Retinal fundus photograph.
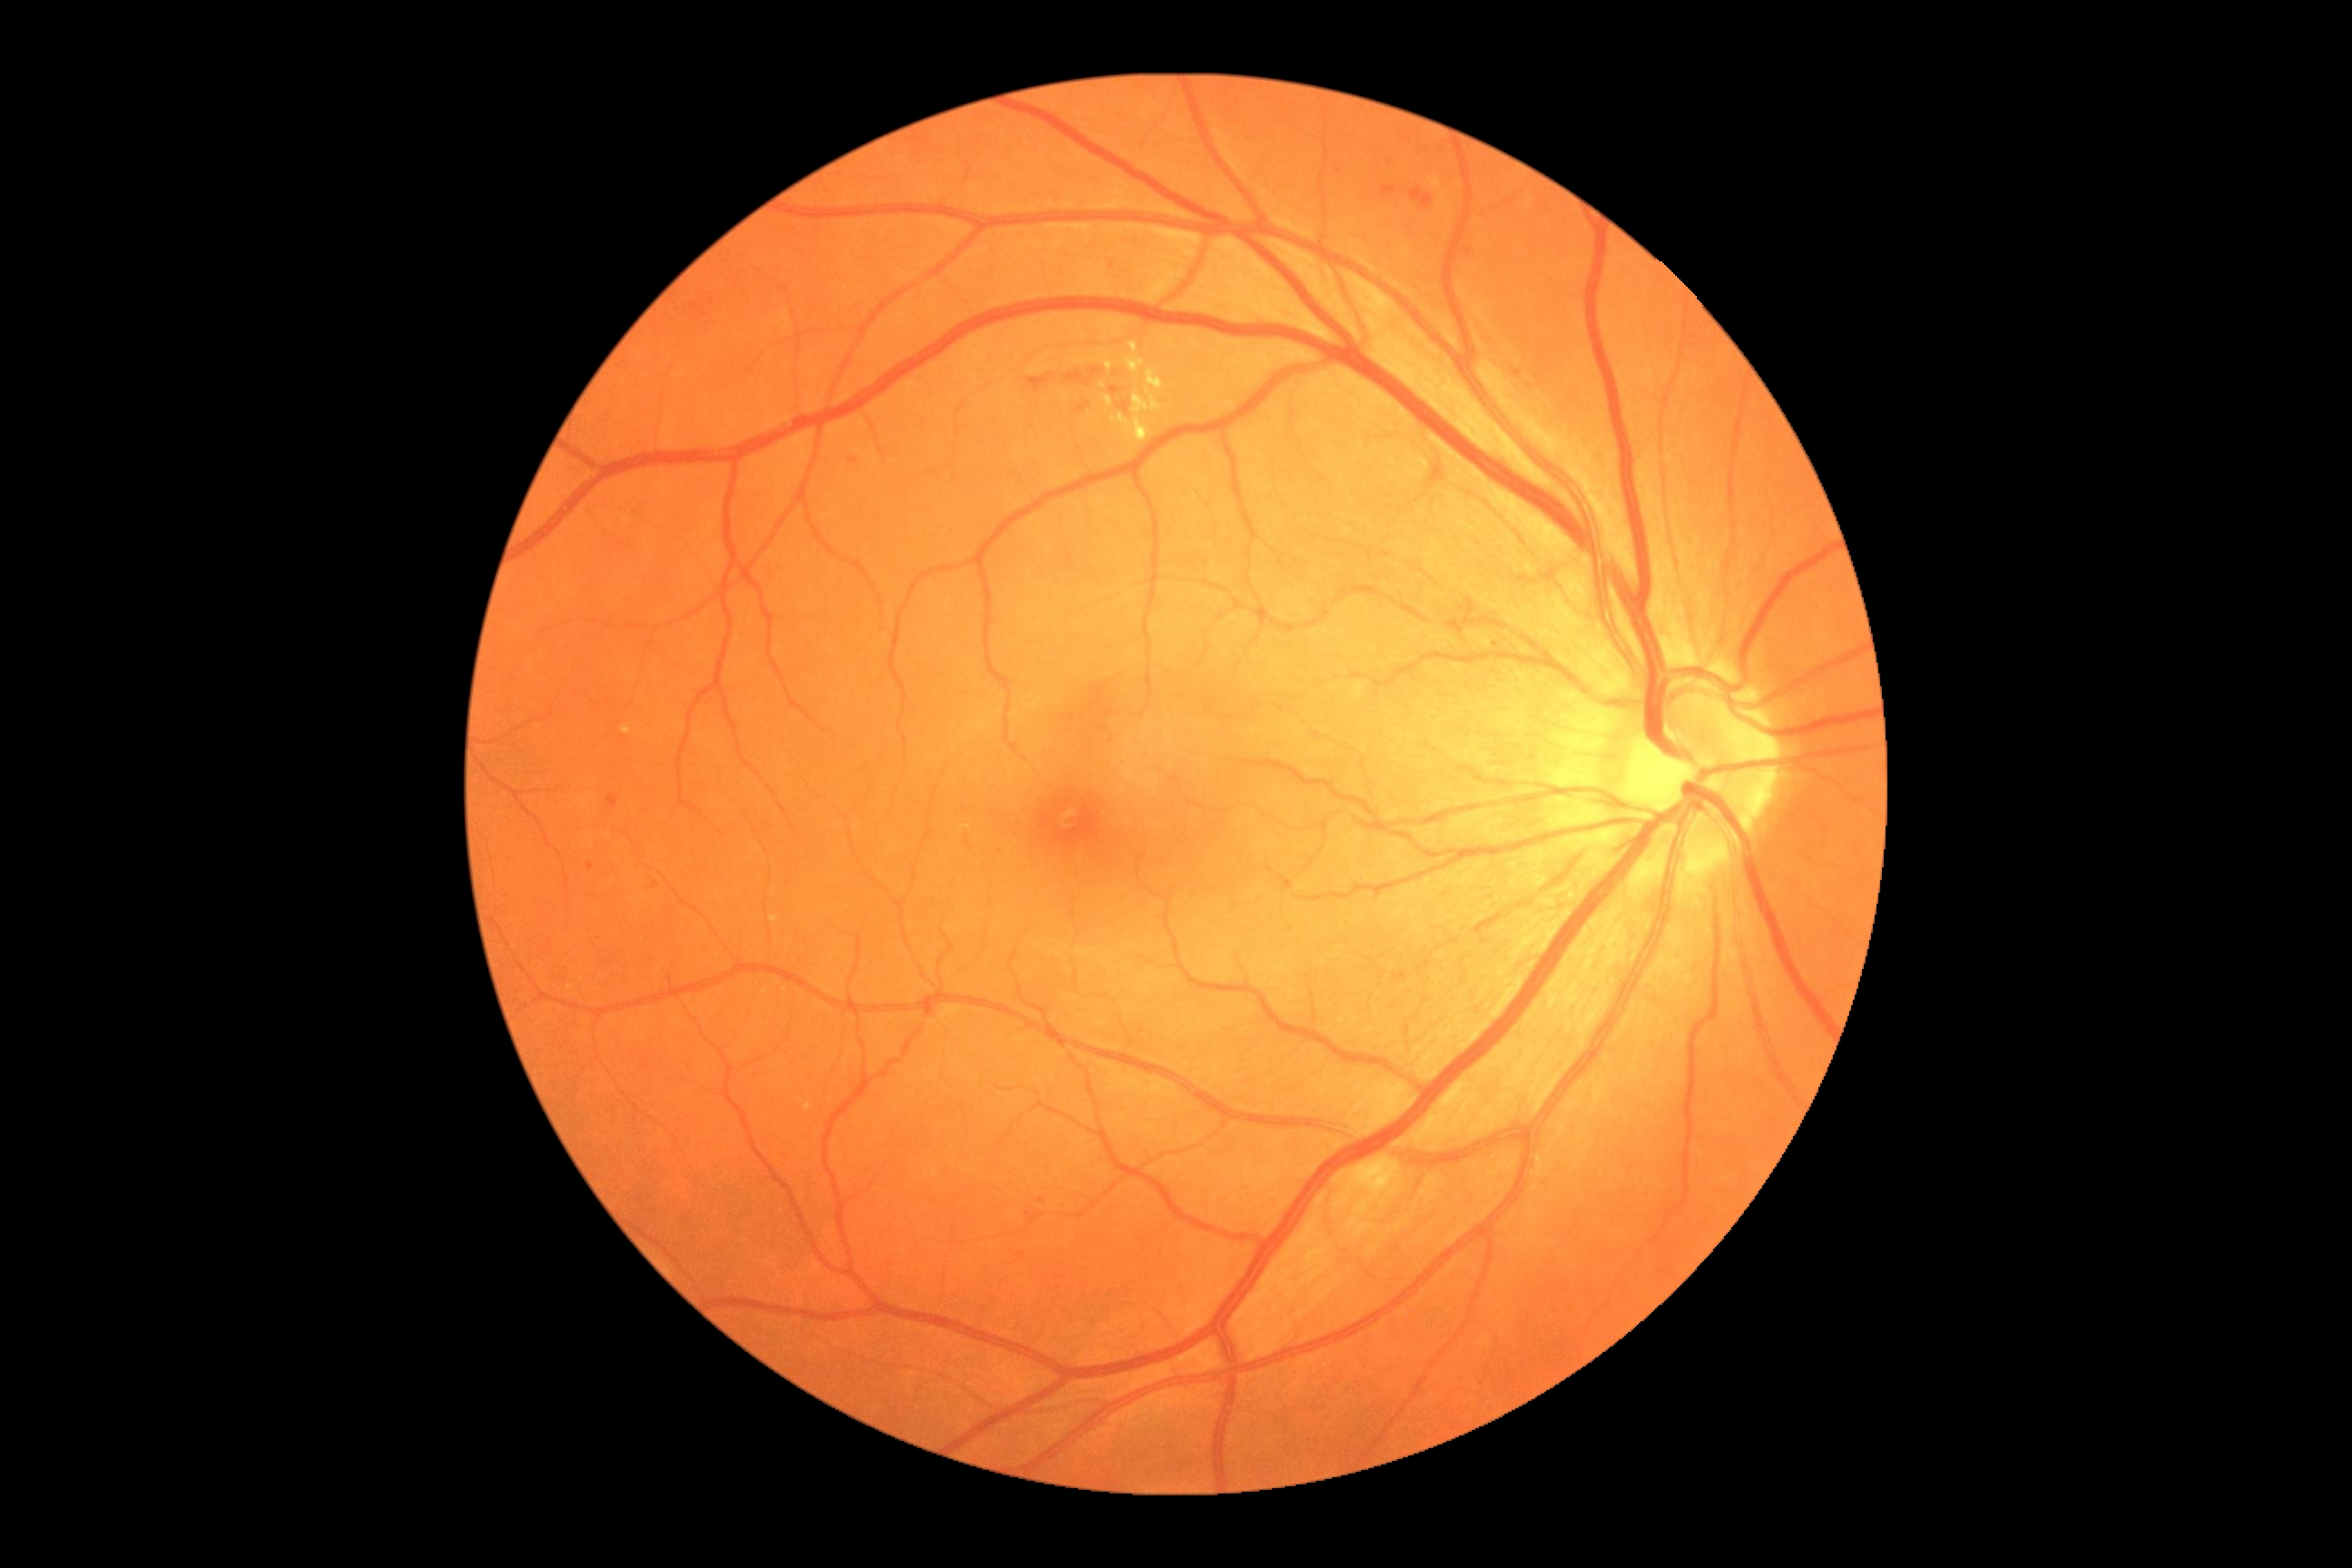 {"dr_grade": 2, "lesions": {"se": null, "ma": null, "ex": [[1106, 362, 1113, 373], [1431, 175, 1453, 211], [1124, 342, 1146, 375], [1104, 397, 1113, 407], [1112, 369, 1164, 444]], "ex_small_centers": [[1103, 386]], "he": [[1380, 186, 1396, 201], [1411, 190, 1435, 210], [1110, 387, 1121, 397], [1088, 369, 1104, 377], [1119, 404, 1130, 415], [1066, 373, 1090, 387], [587, 863, 594, 872], [1026, 375, 1052, 393], [1491, 643, 1500, 651], [607, 794, 618, 808], [1077, 402, 1090, 415], [850, 458, 858, 466]], "he_small_centers": [[1470, 252], [1042, 1201], [656, 885]]}}